Wide-field fundus photograph from neonatal ROP screening. 130° field of view (Natus RetCam Envision). Image size 1440x1080:
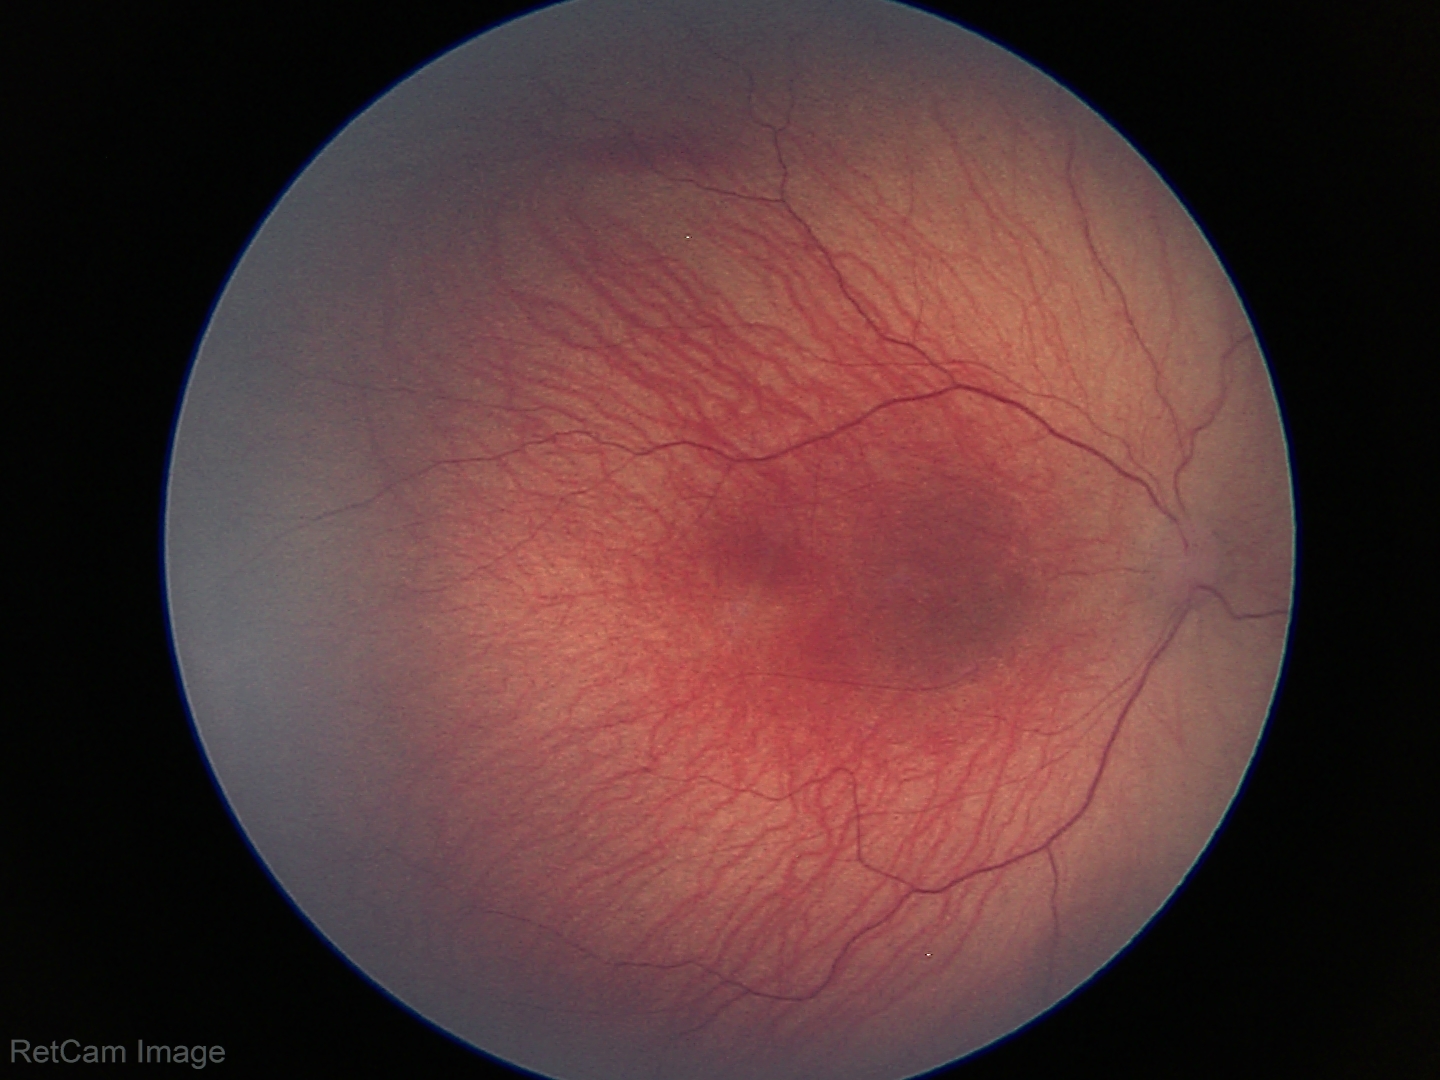
Q: What was the screening finding?
A: retinopathy of prematurity (ROP) stage 1 — demarcation line between vascular and avascular retina